Optic disc-centered crop; fundus photo
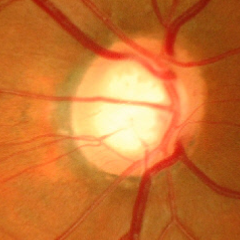
Glaucoma assessment = advanced glaucomatous optic neuropathy.